Modified Davis classification. 45° FOV. 848x848px. Camera: NIDEK AFC-230.
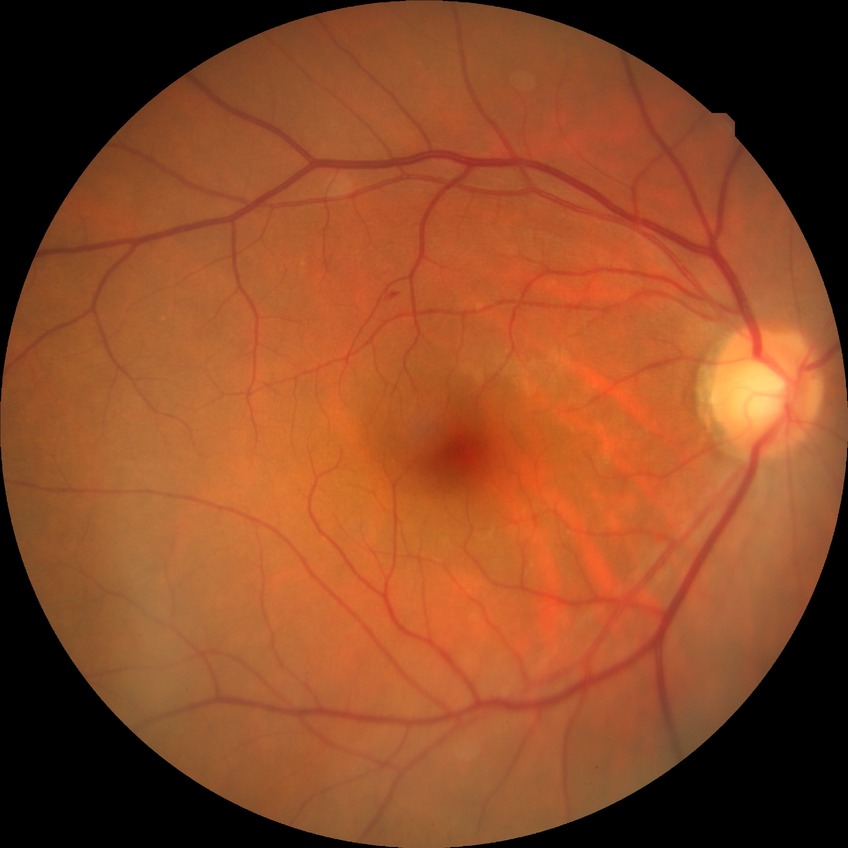

Annotations:
– diabetic retinopathy (DR): SDR (simple diabetic retinopathy)